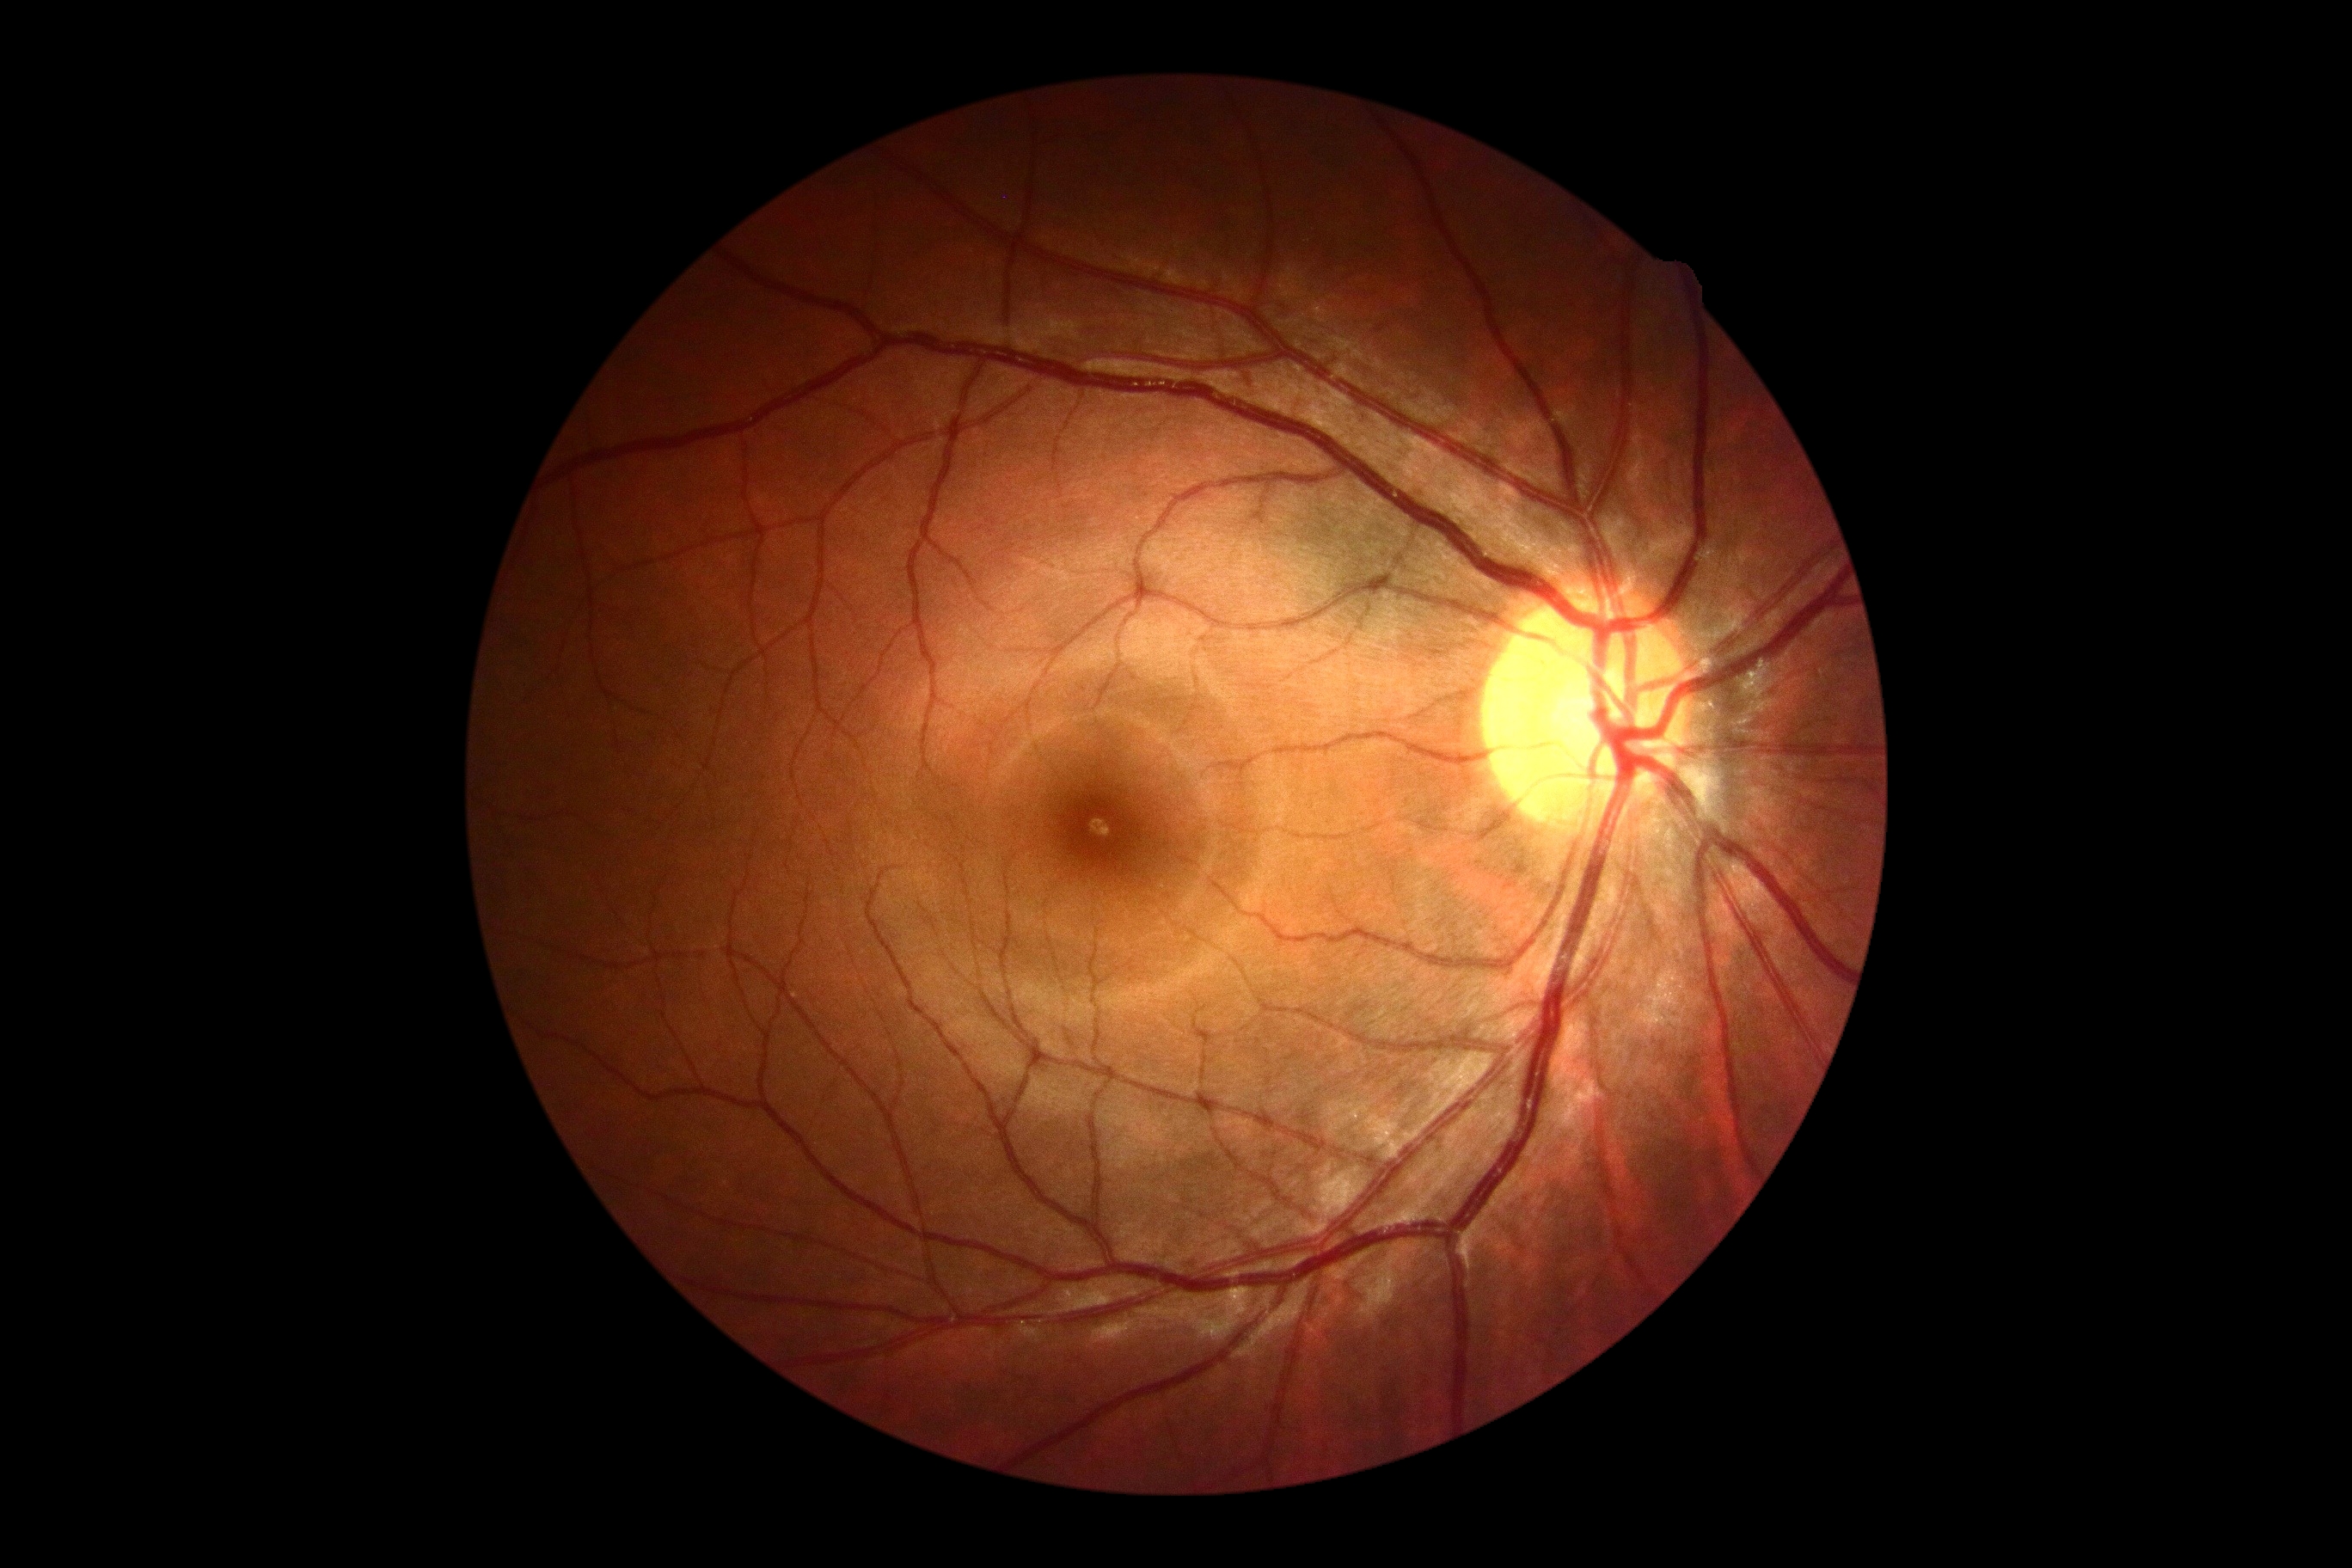
Diabetic retinopathy is no apparent retinopathy (grade 0) — no visible signs of diabetic retinopathy.